Pediatric wide-field fundus photograph · 1240x1240 · 100° field of view (Phoenix ICON)
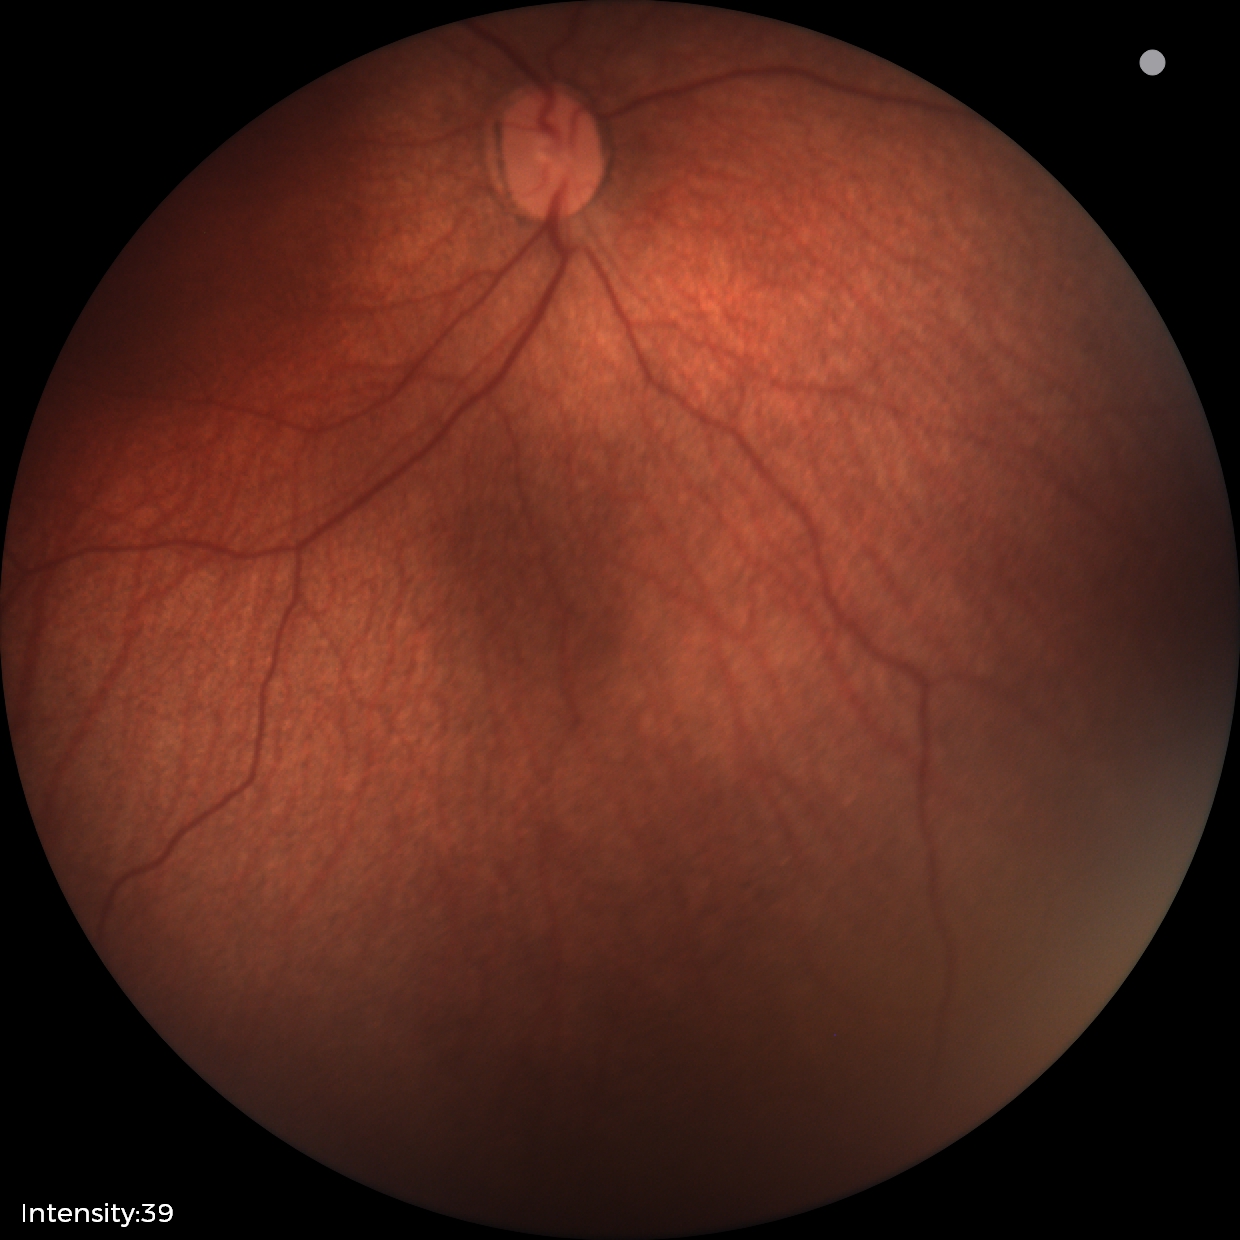 Finding = status post ROP